Camera: NIDEK AFC-230. No pharmacologic dilation. Fundus photo. 45° field of view:
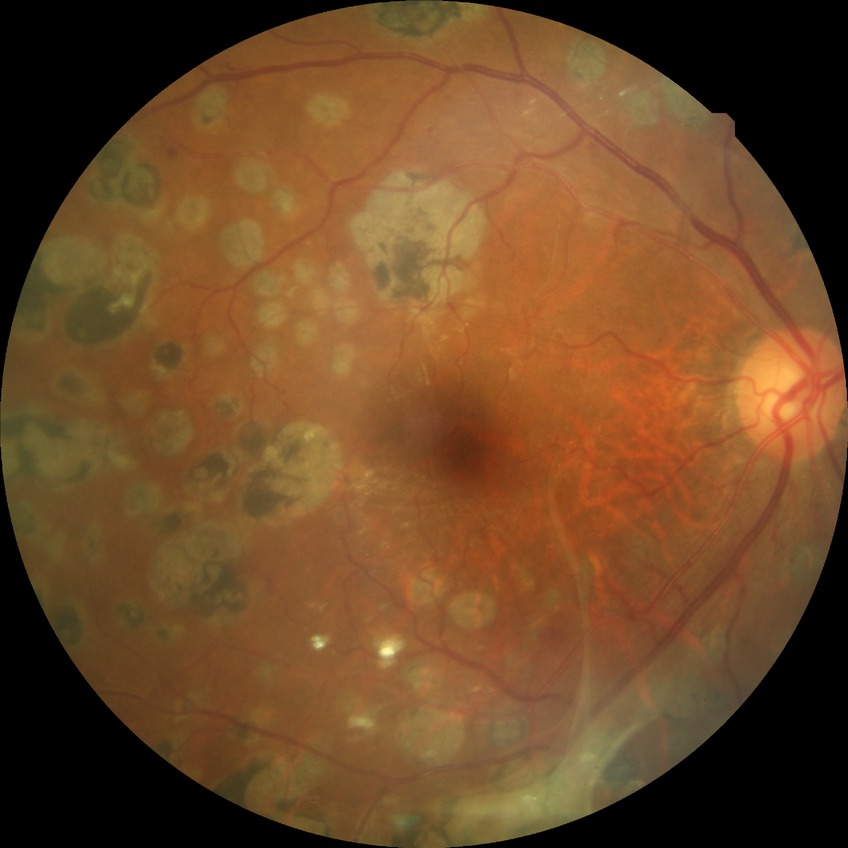 {
  "davis_grade": "PDR"
}